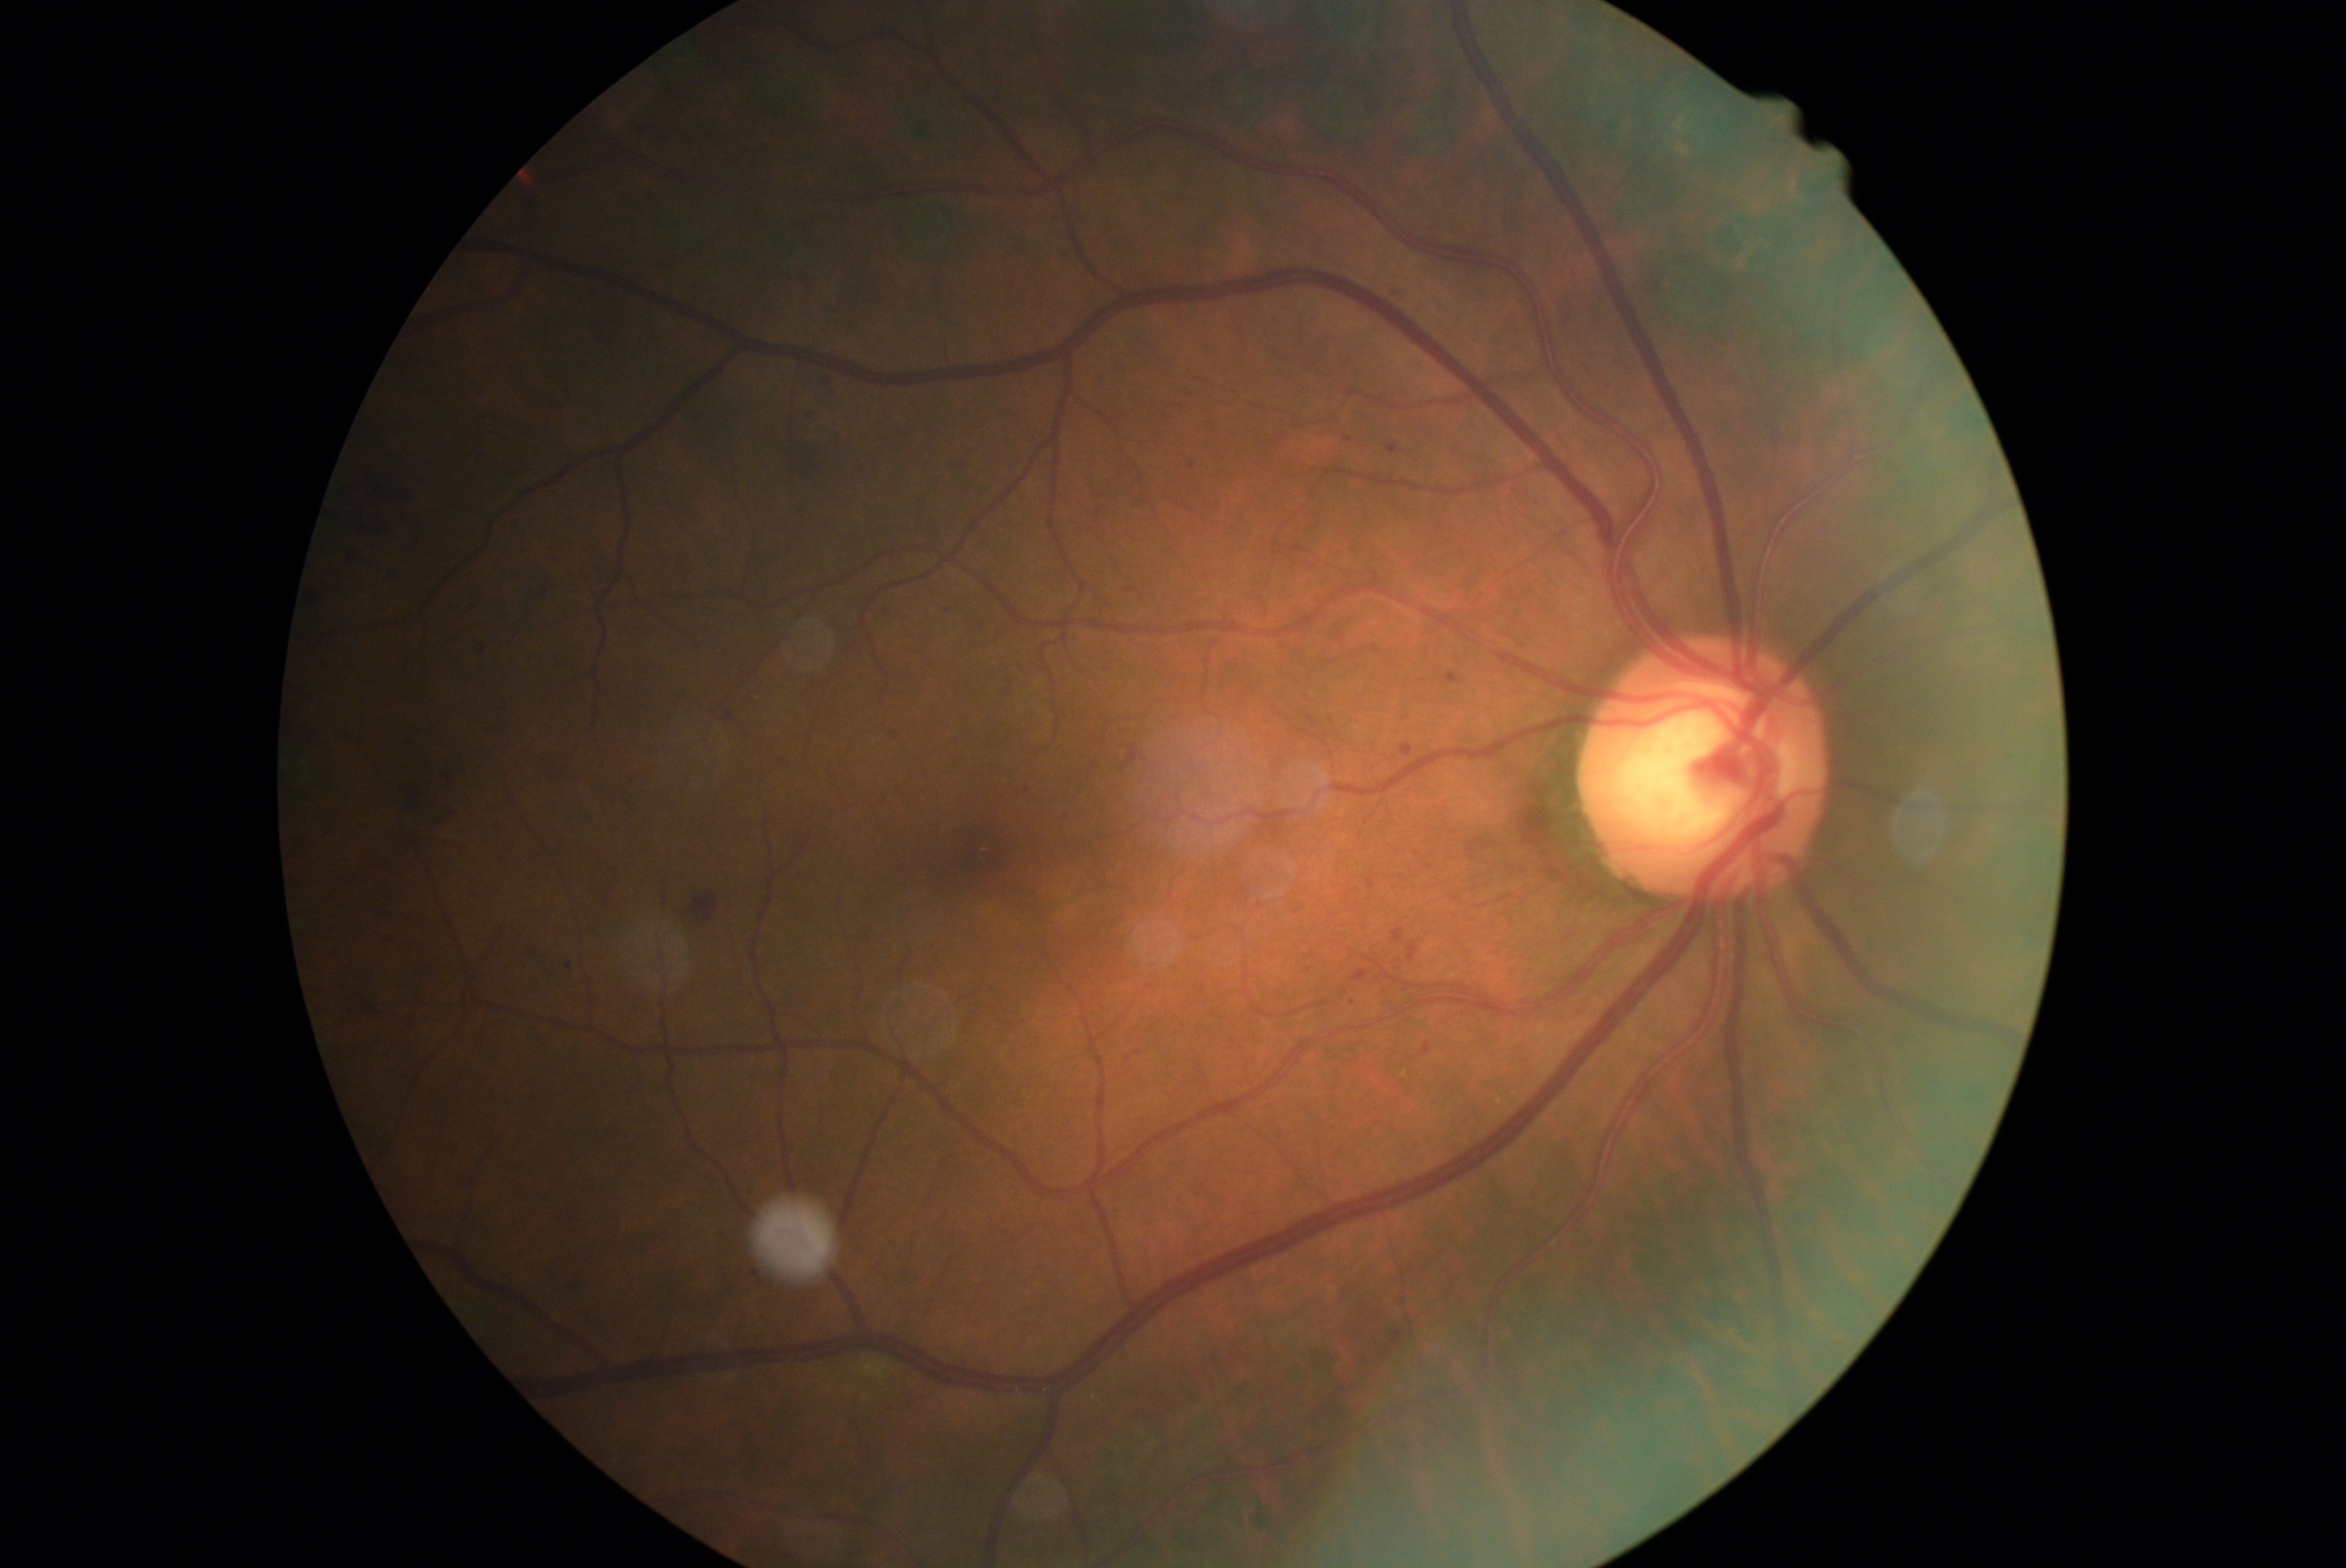
DR class@non-proliferative diabetic retinopathy, diabetic retinopathy grade@2 (moderate NPDR) — more than just microaneurysms but less than severe NPDR.